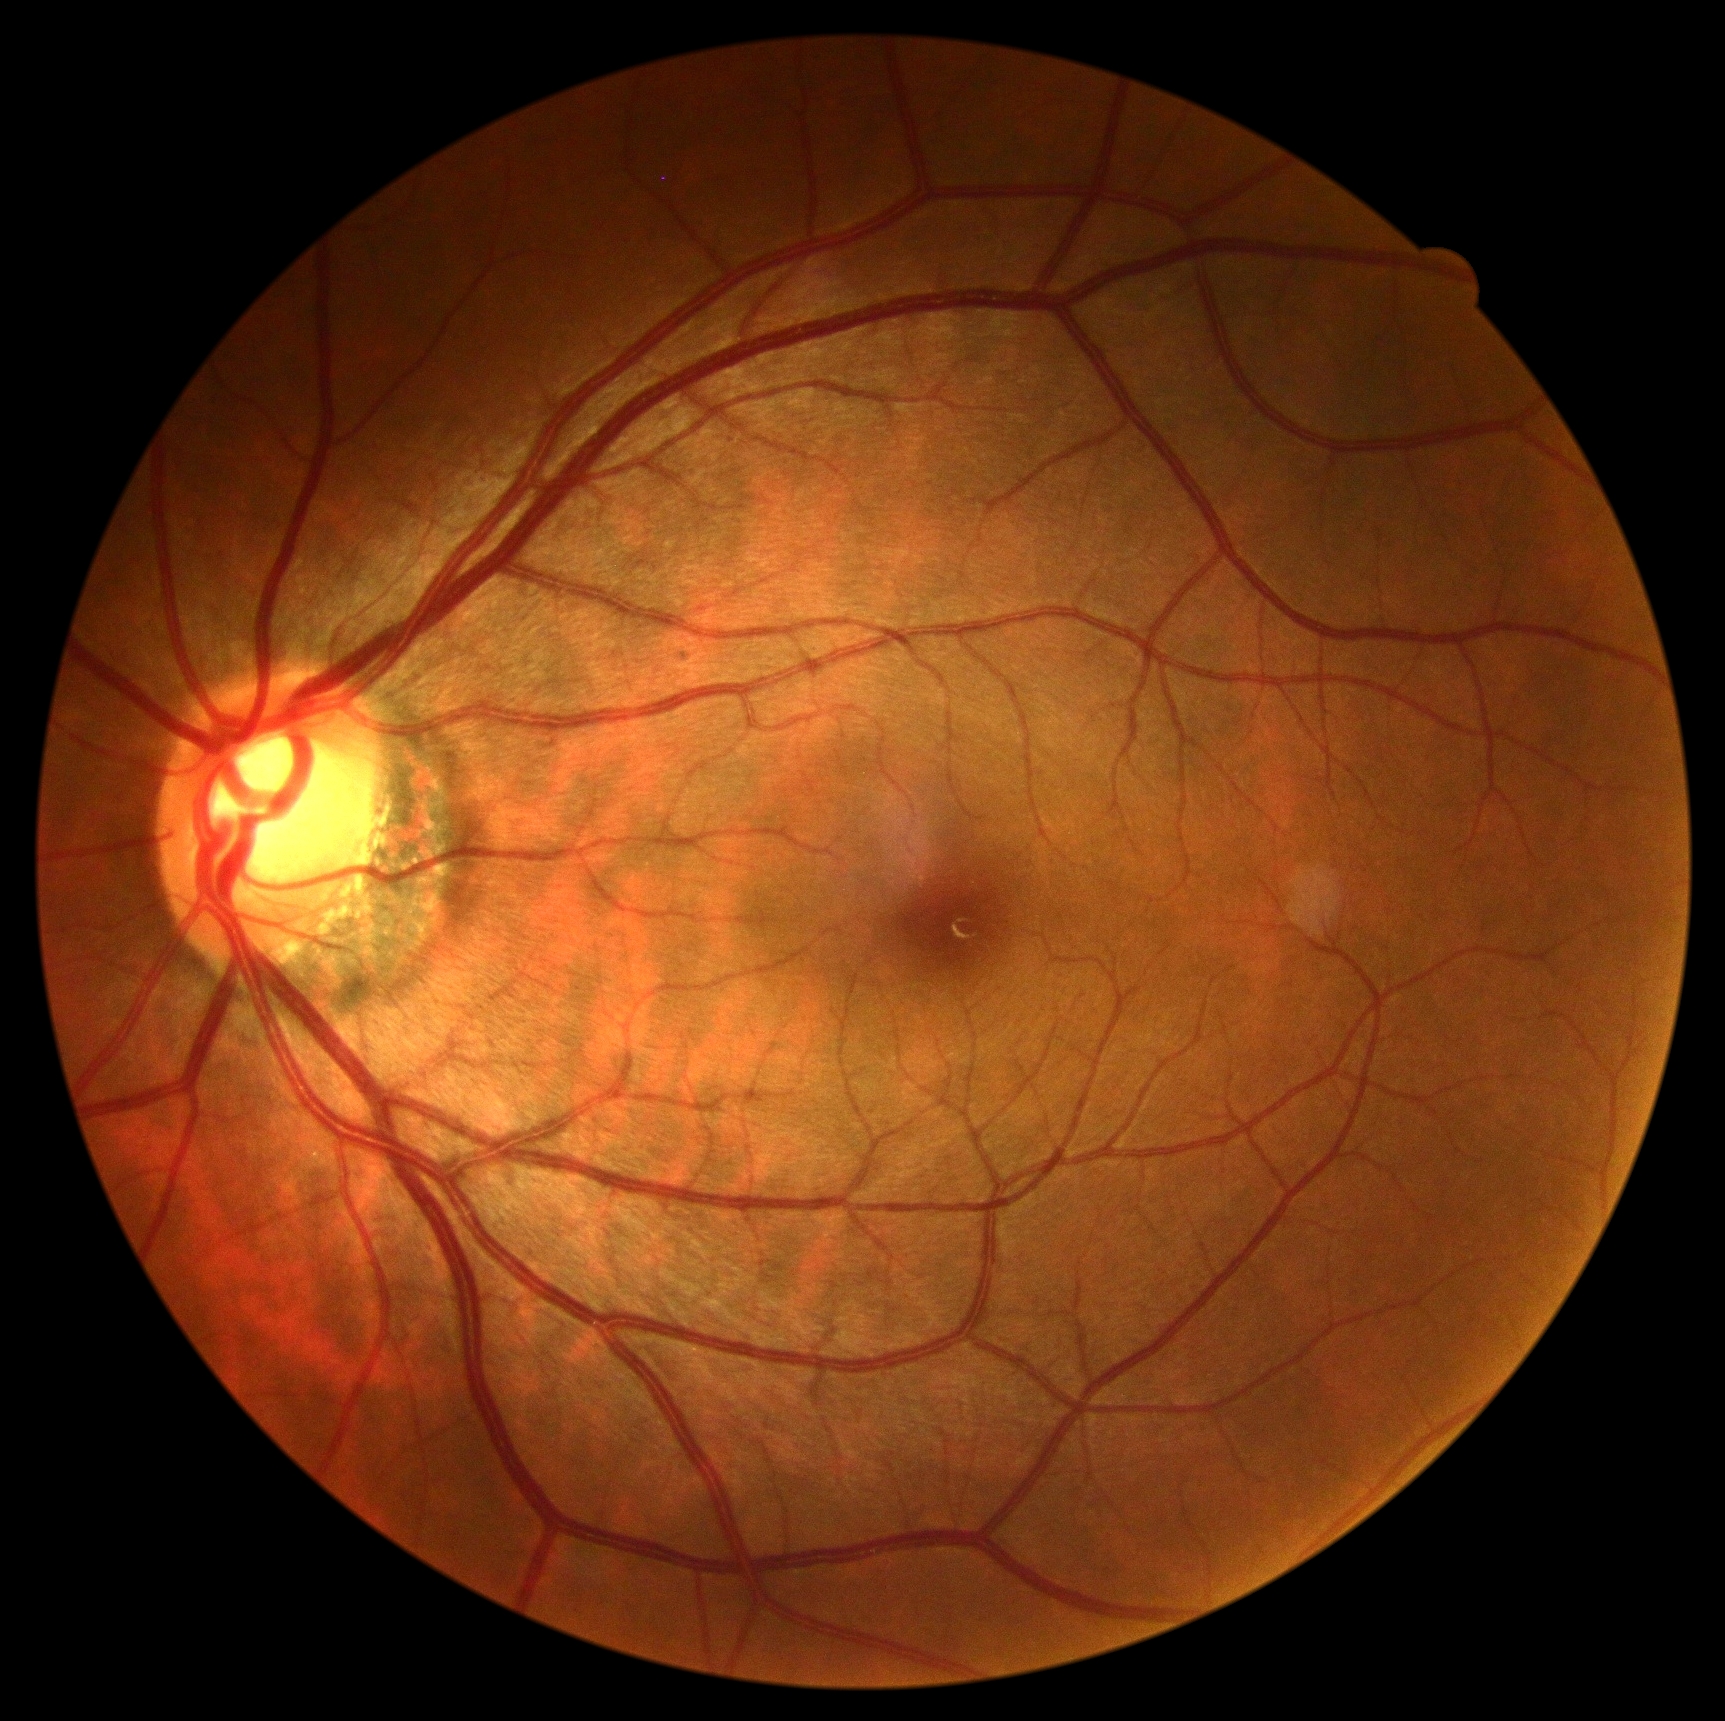

  dr_impression: negative for DR
  dr_grade: 0